Retinal fundus photograph — 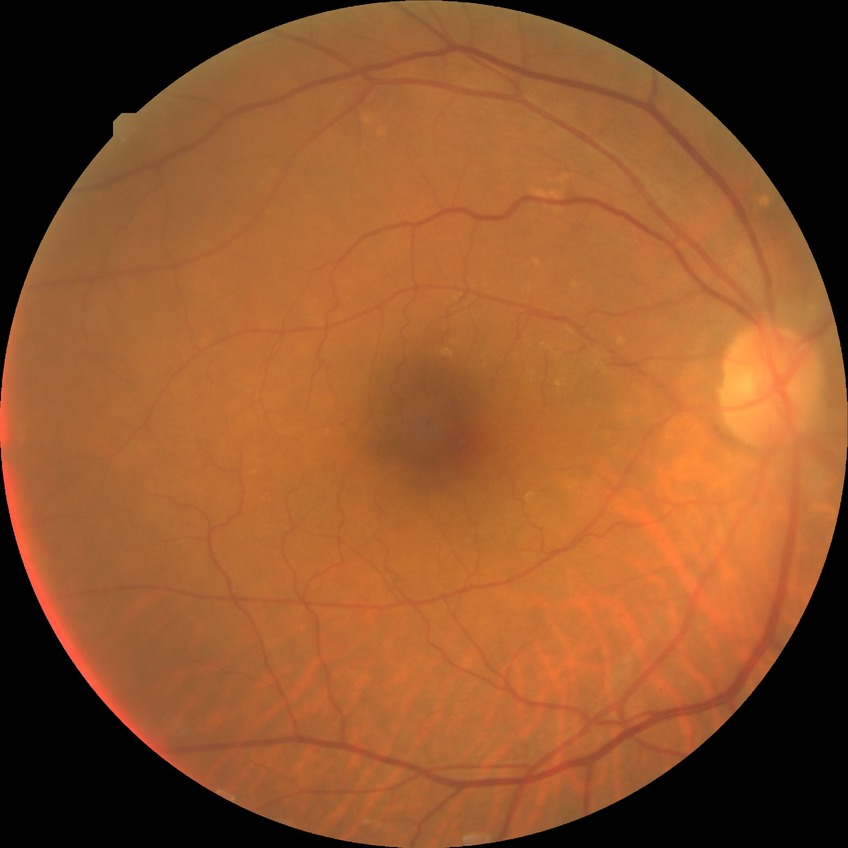 retinopathy stage: no diabetic retinopathy.